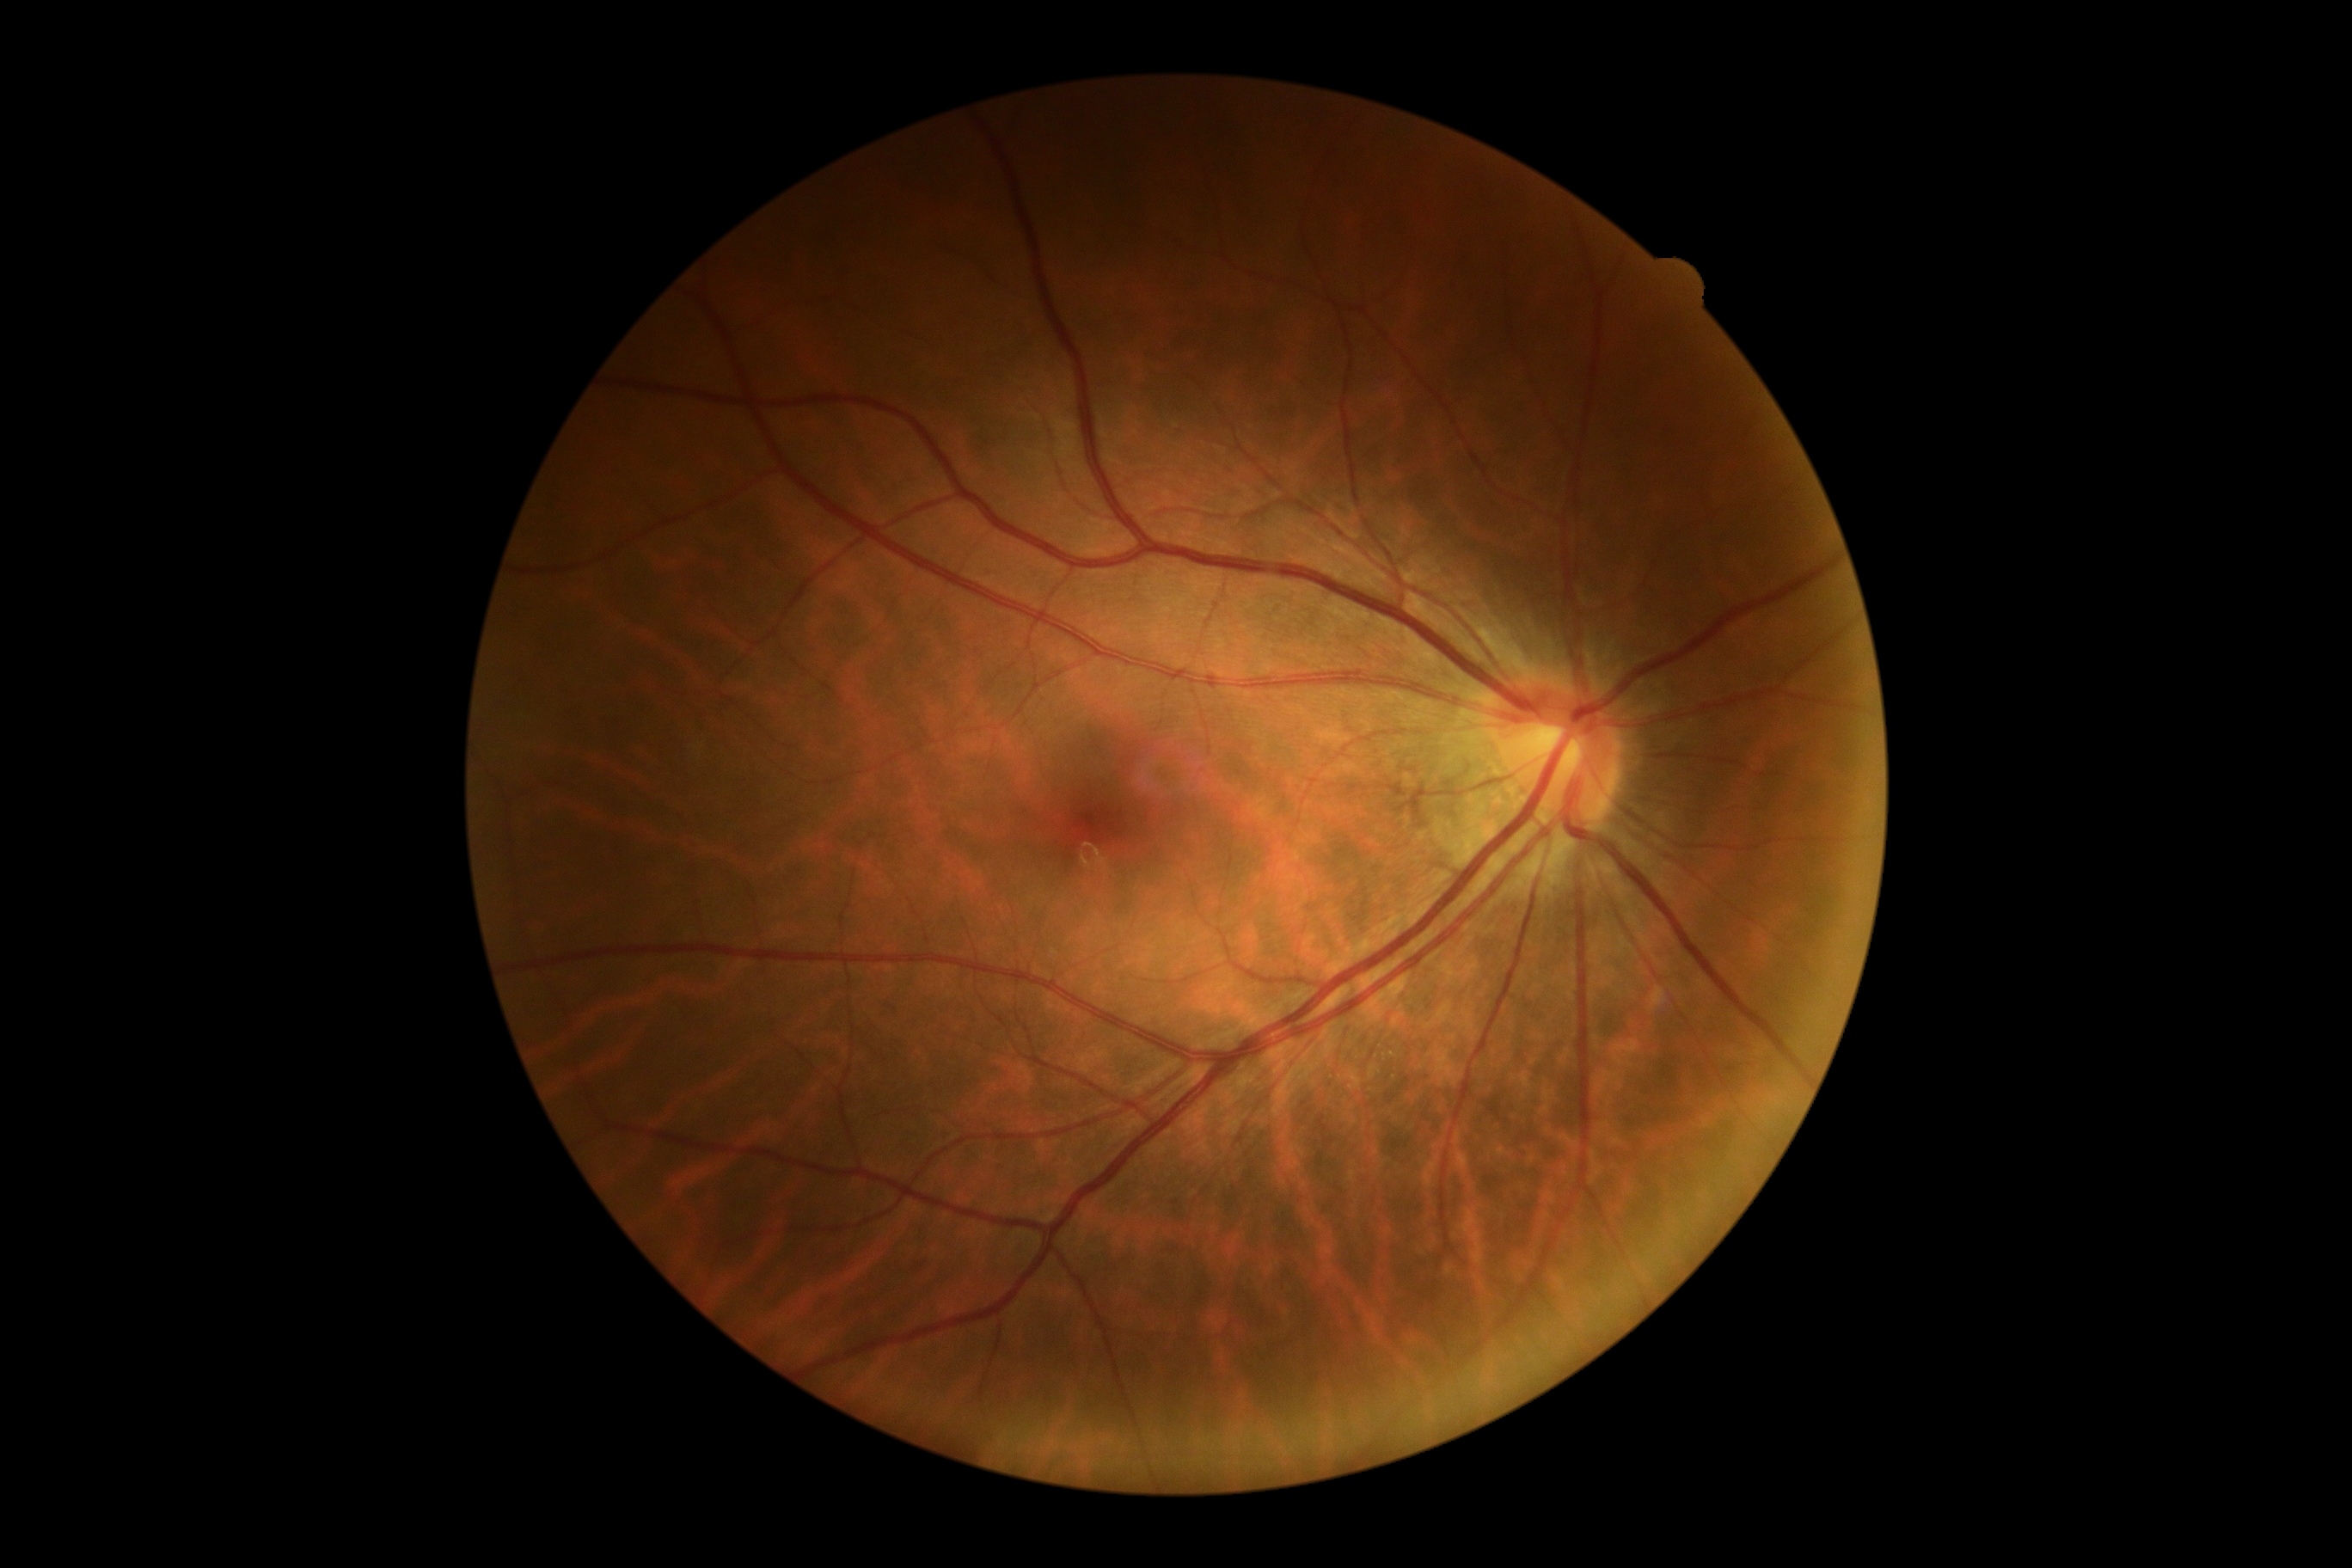
Annotations:
• DR severity: grade 0